CFP.
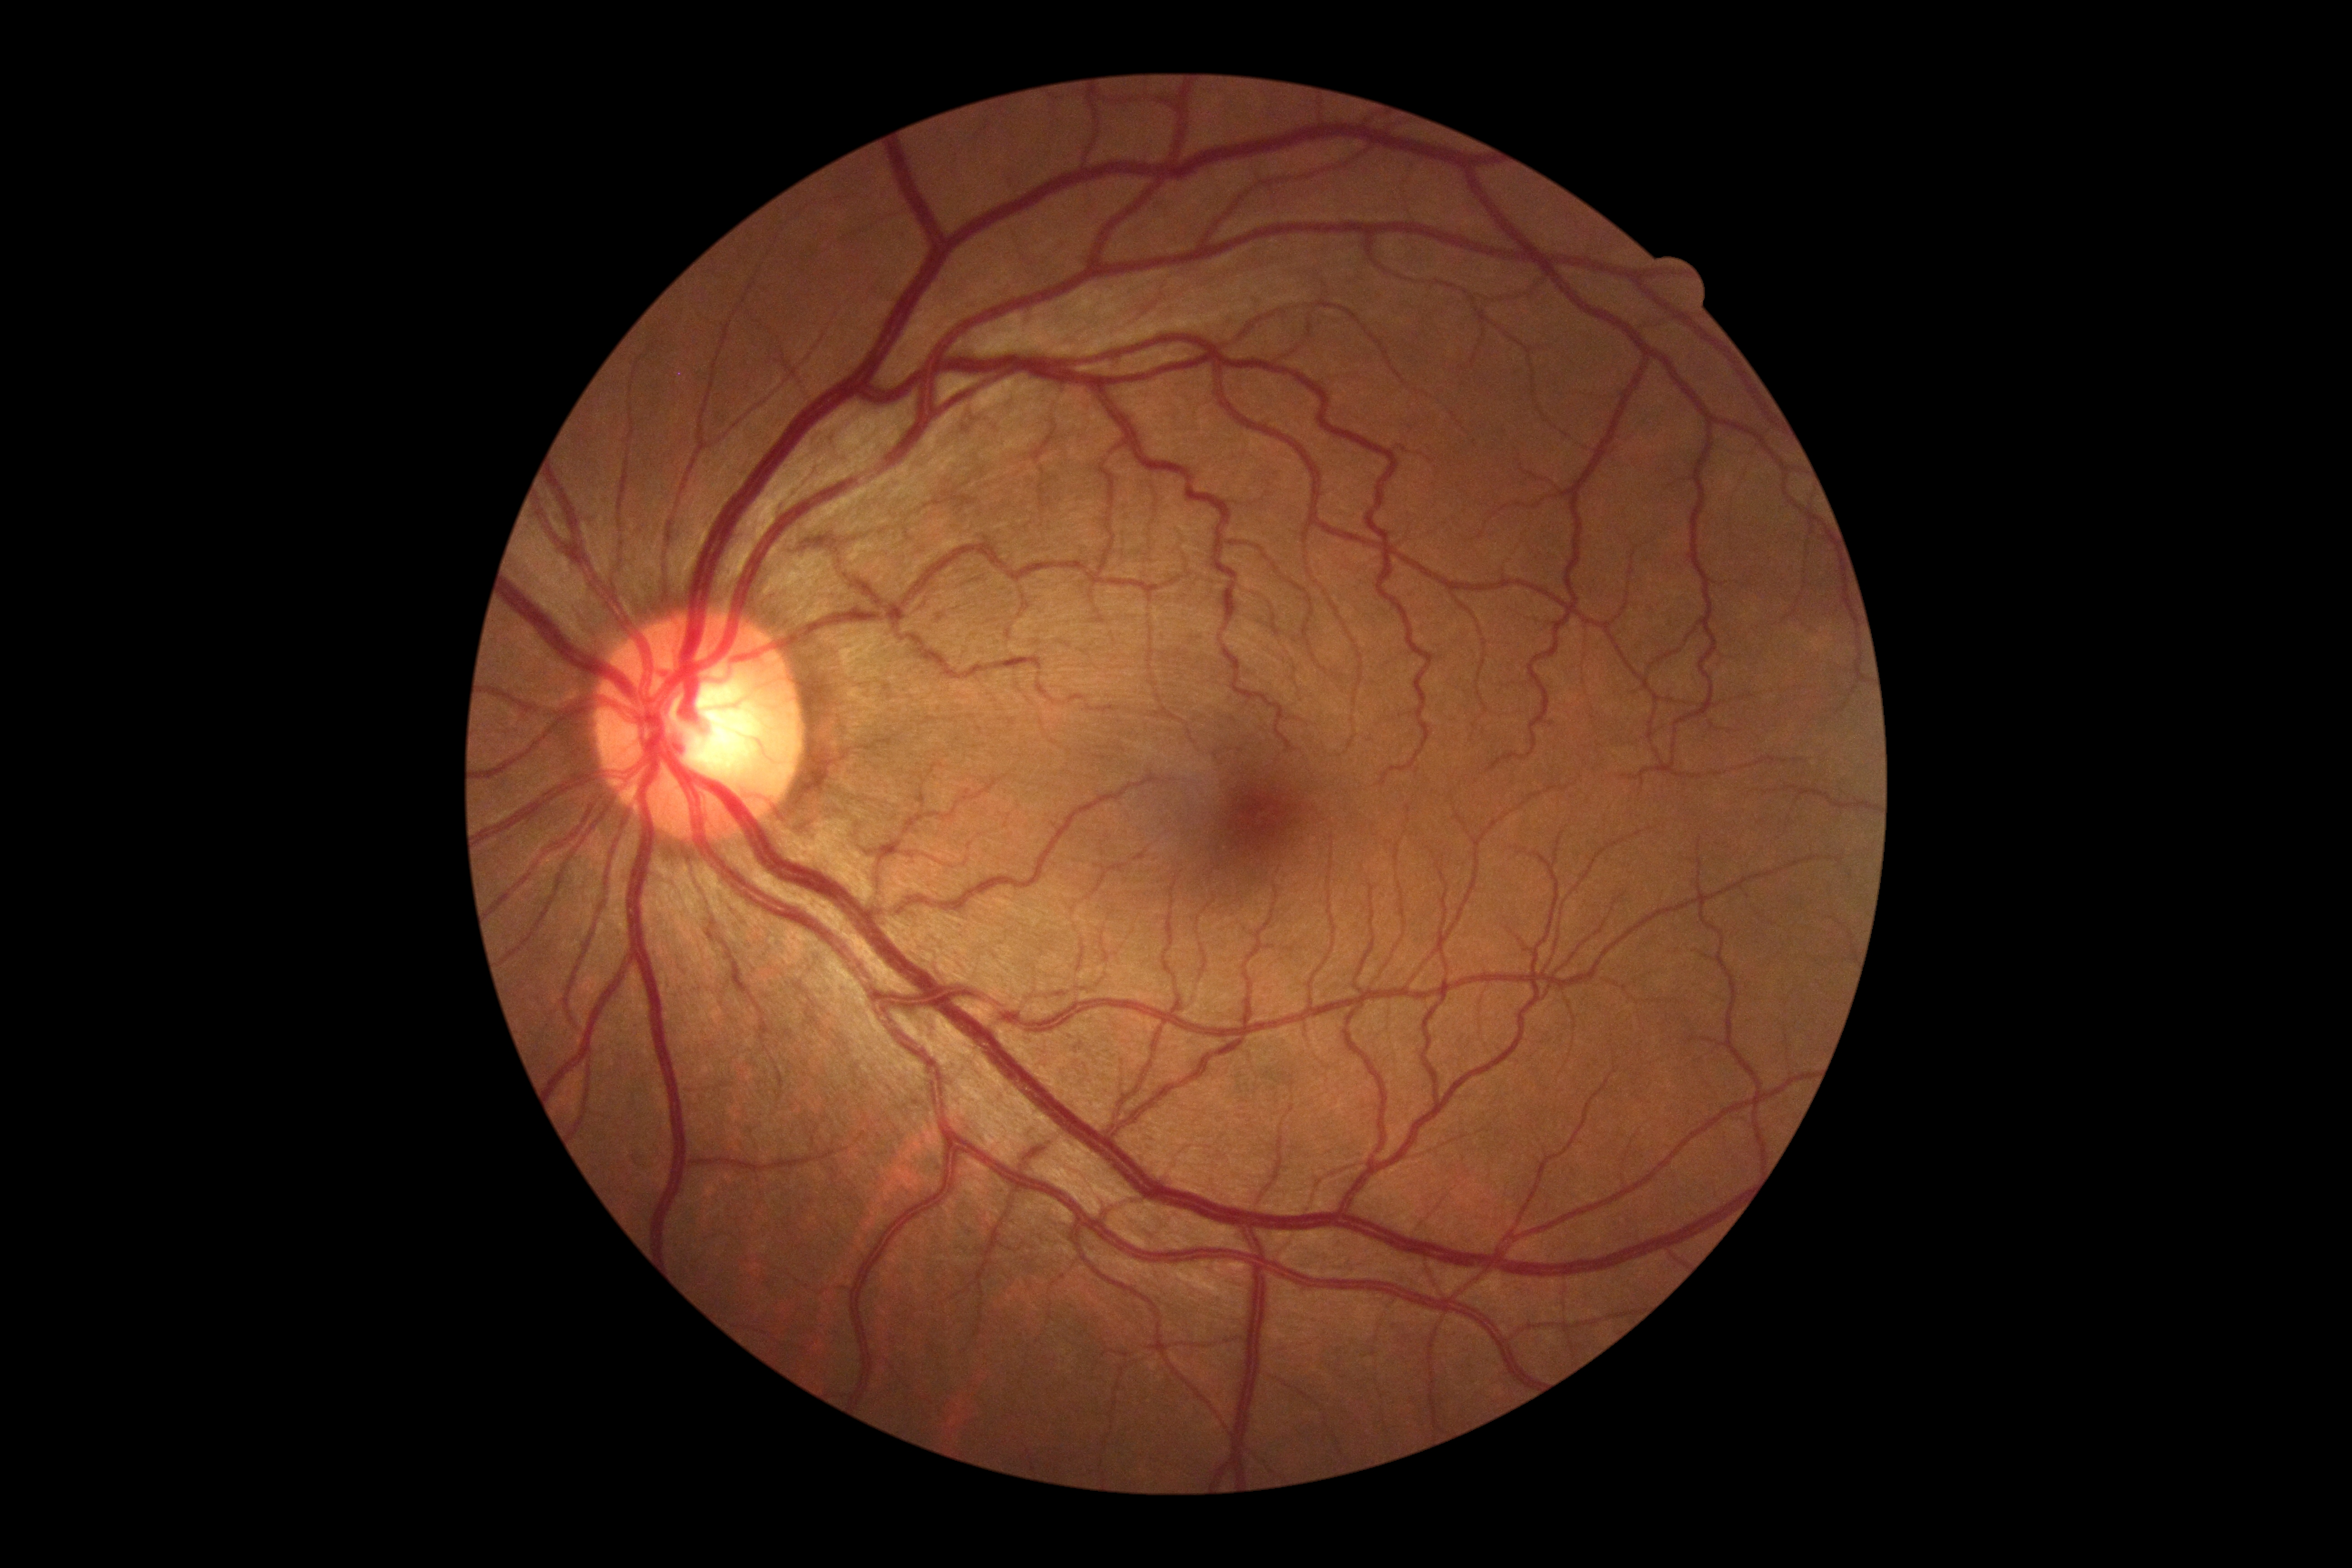 Diabetic retinopathy (DR) is grade 0 (no apparent retinopathy) — no visible signs of diabetic retinopathy.